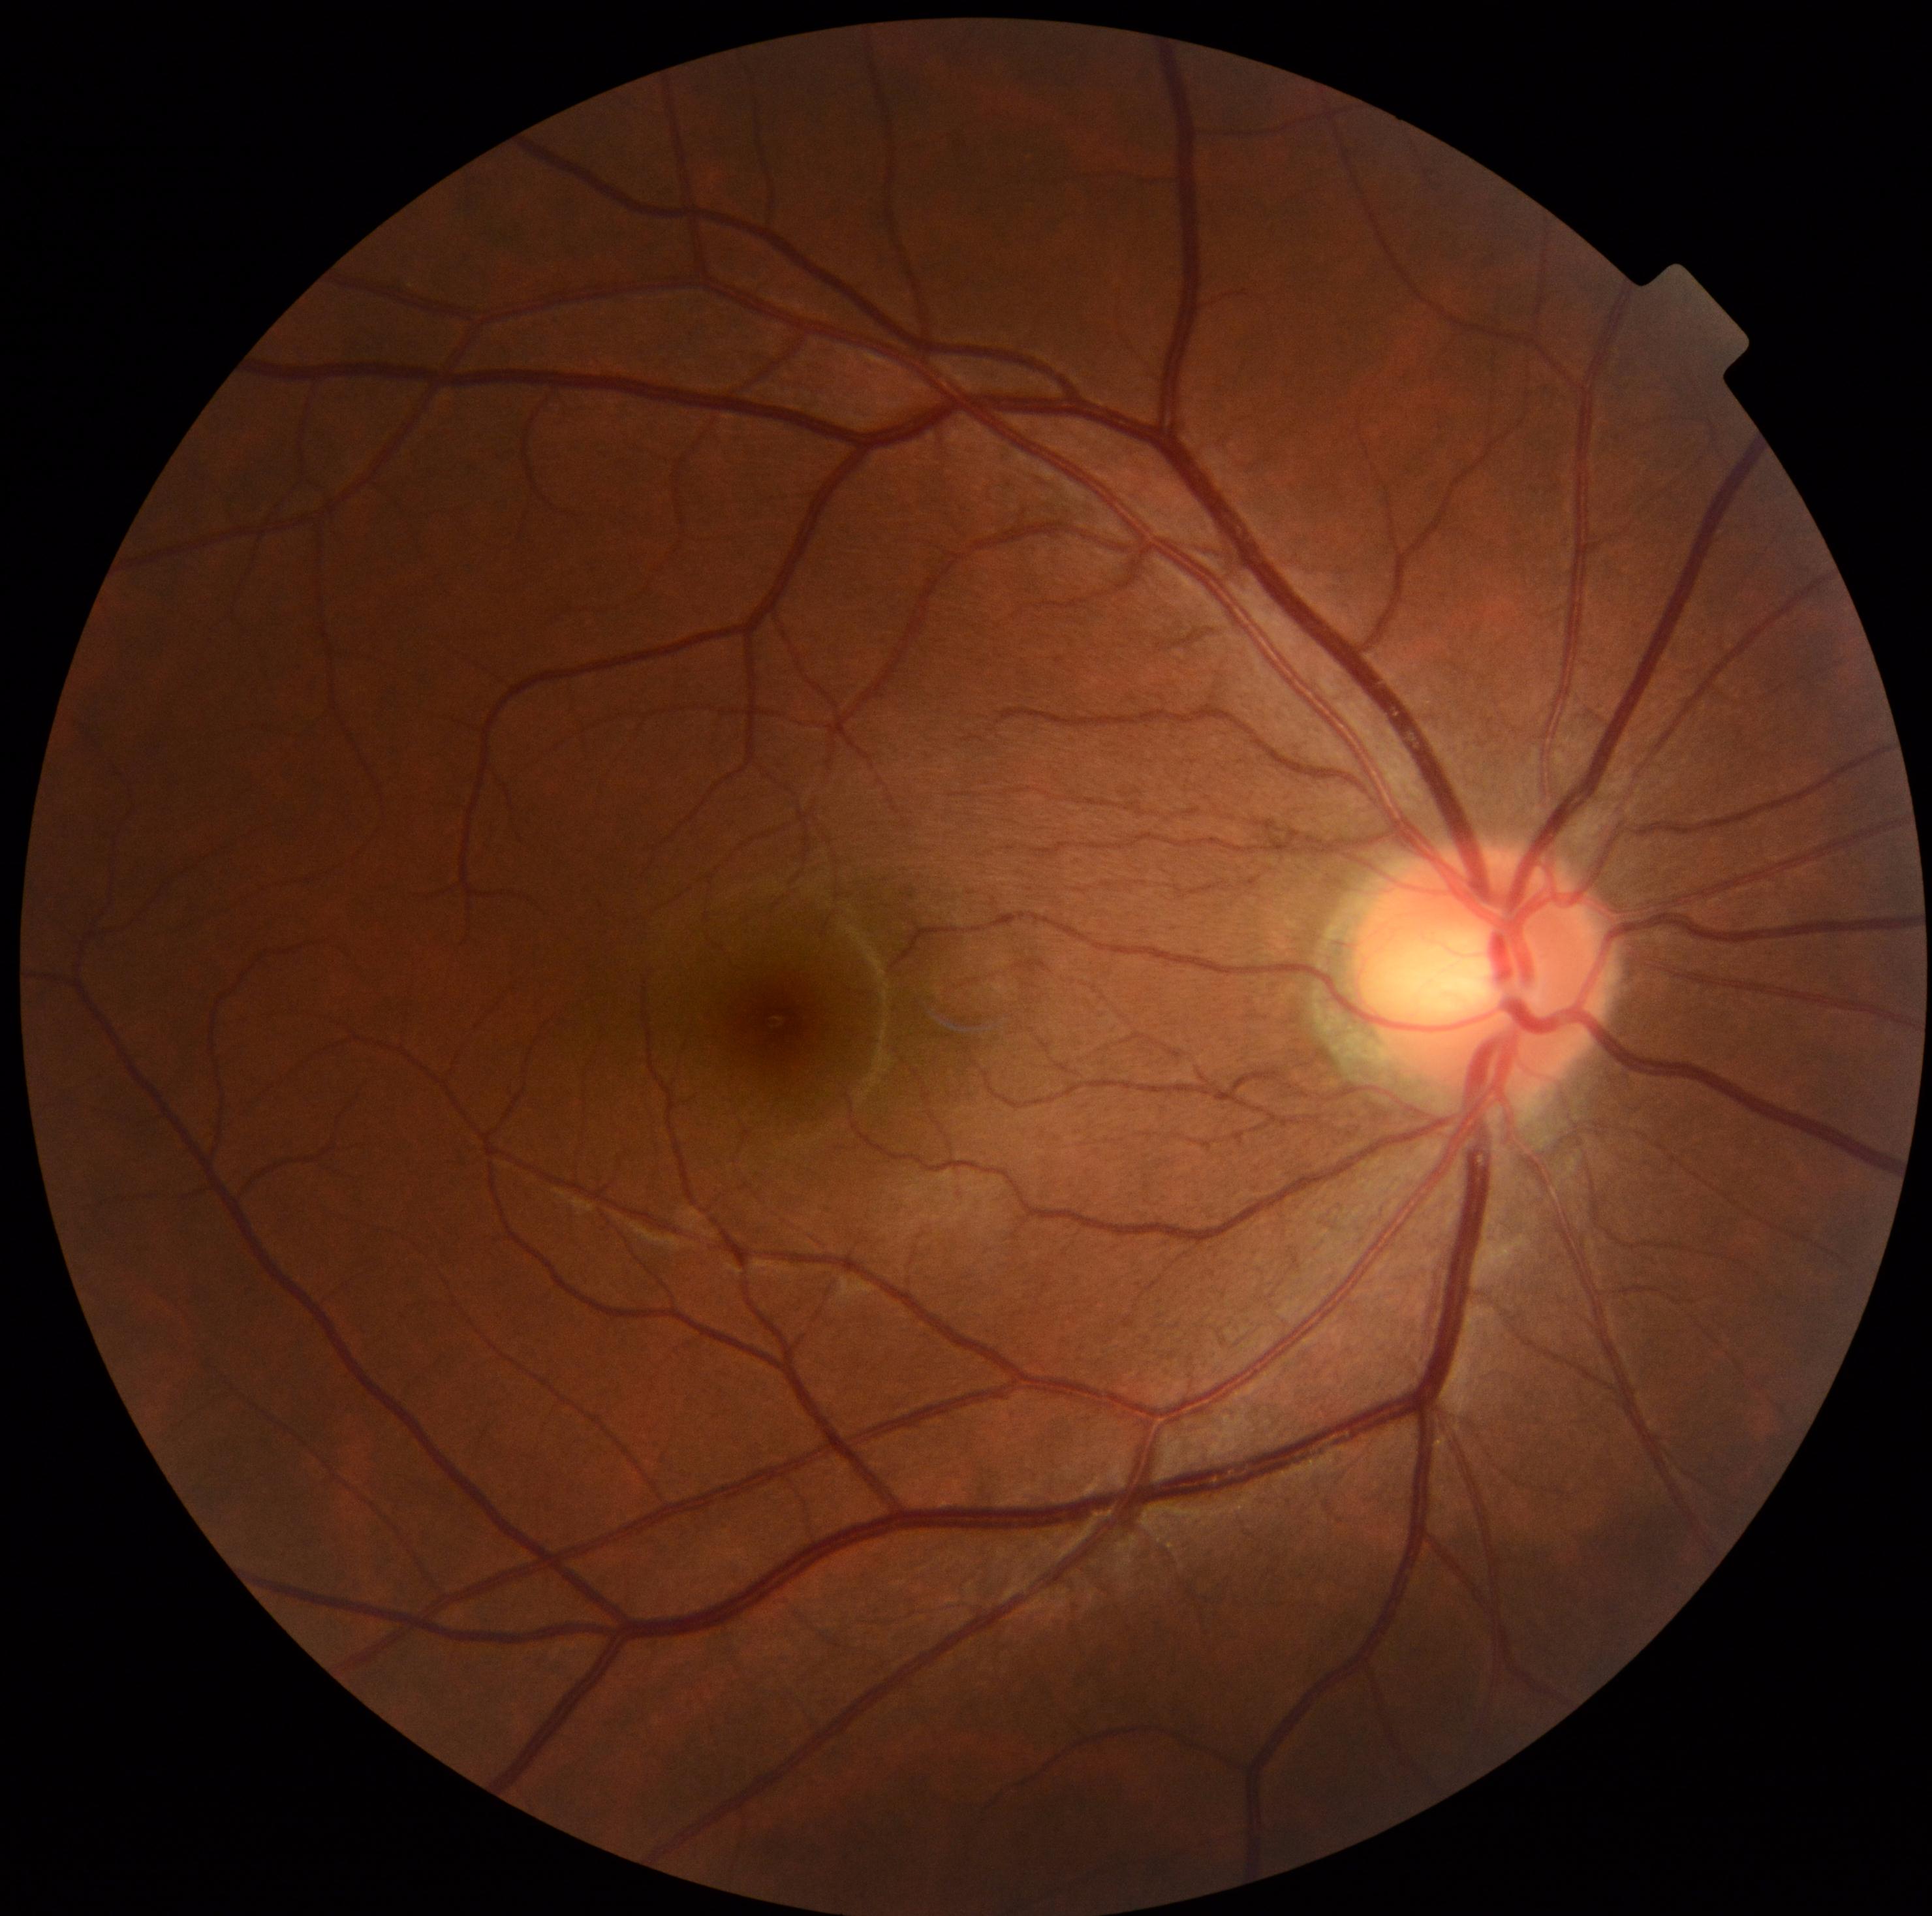
{
  "dr_grade": "0 (no apparent retinopathy)"
}